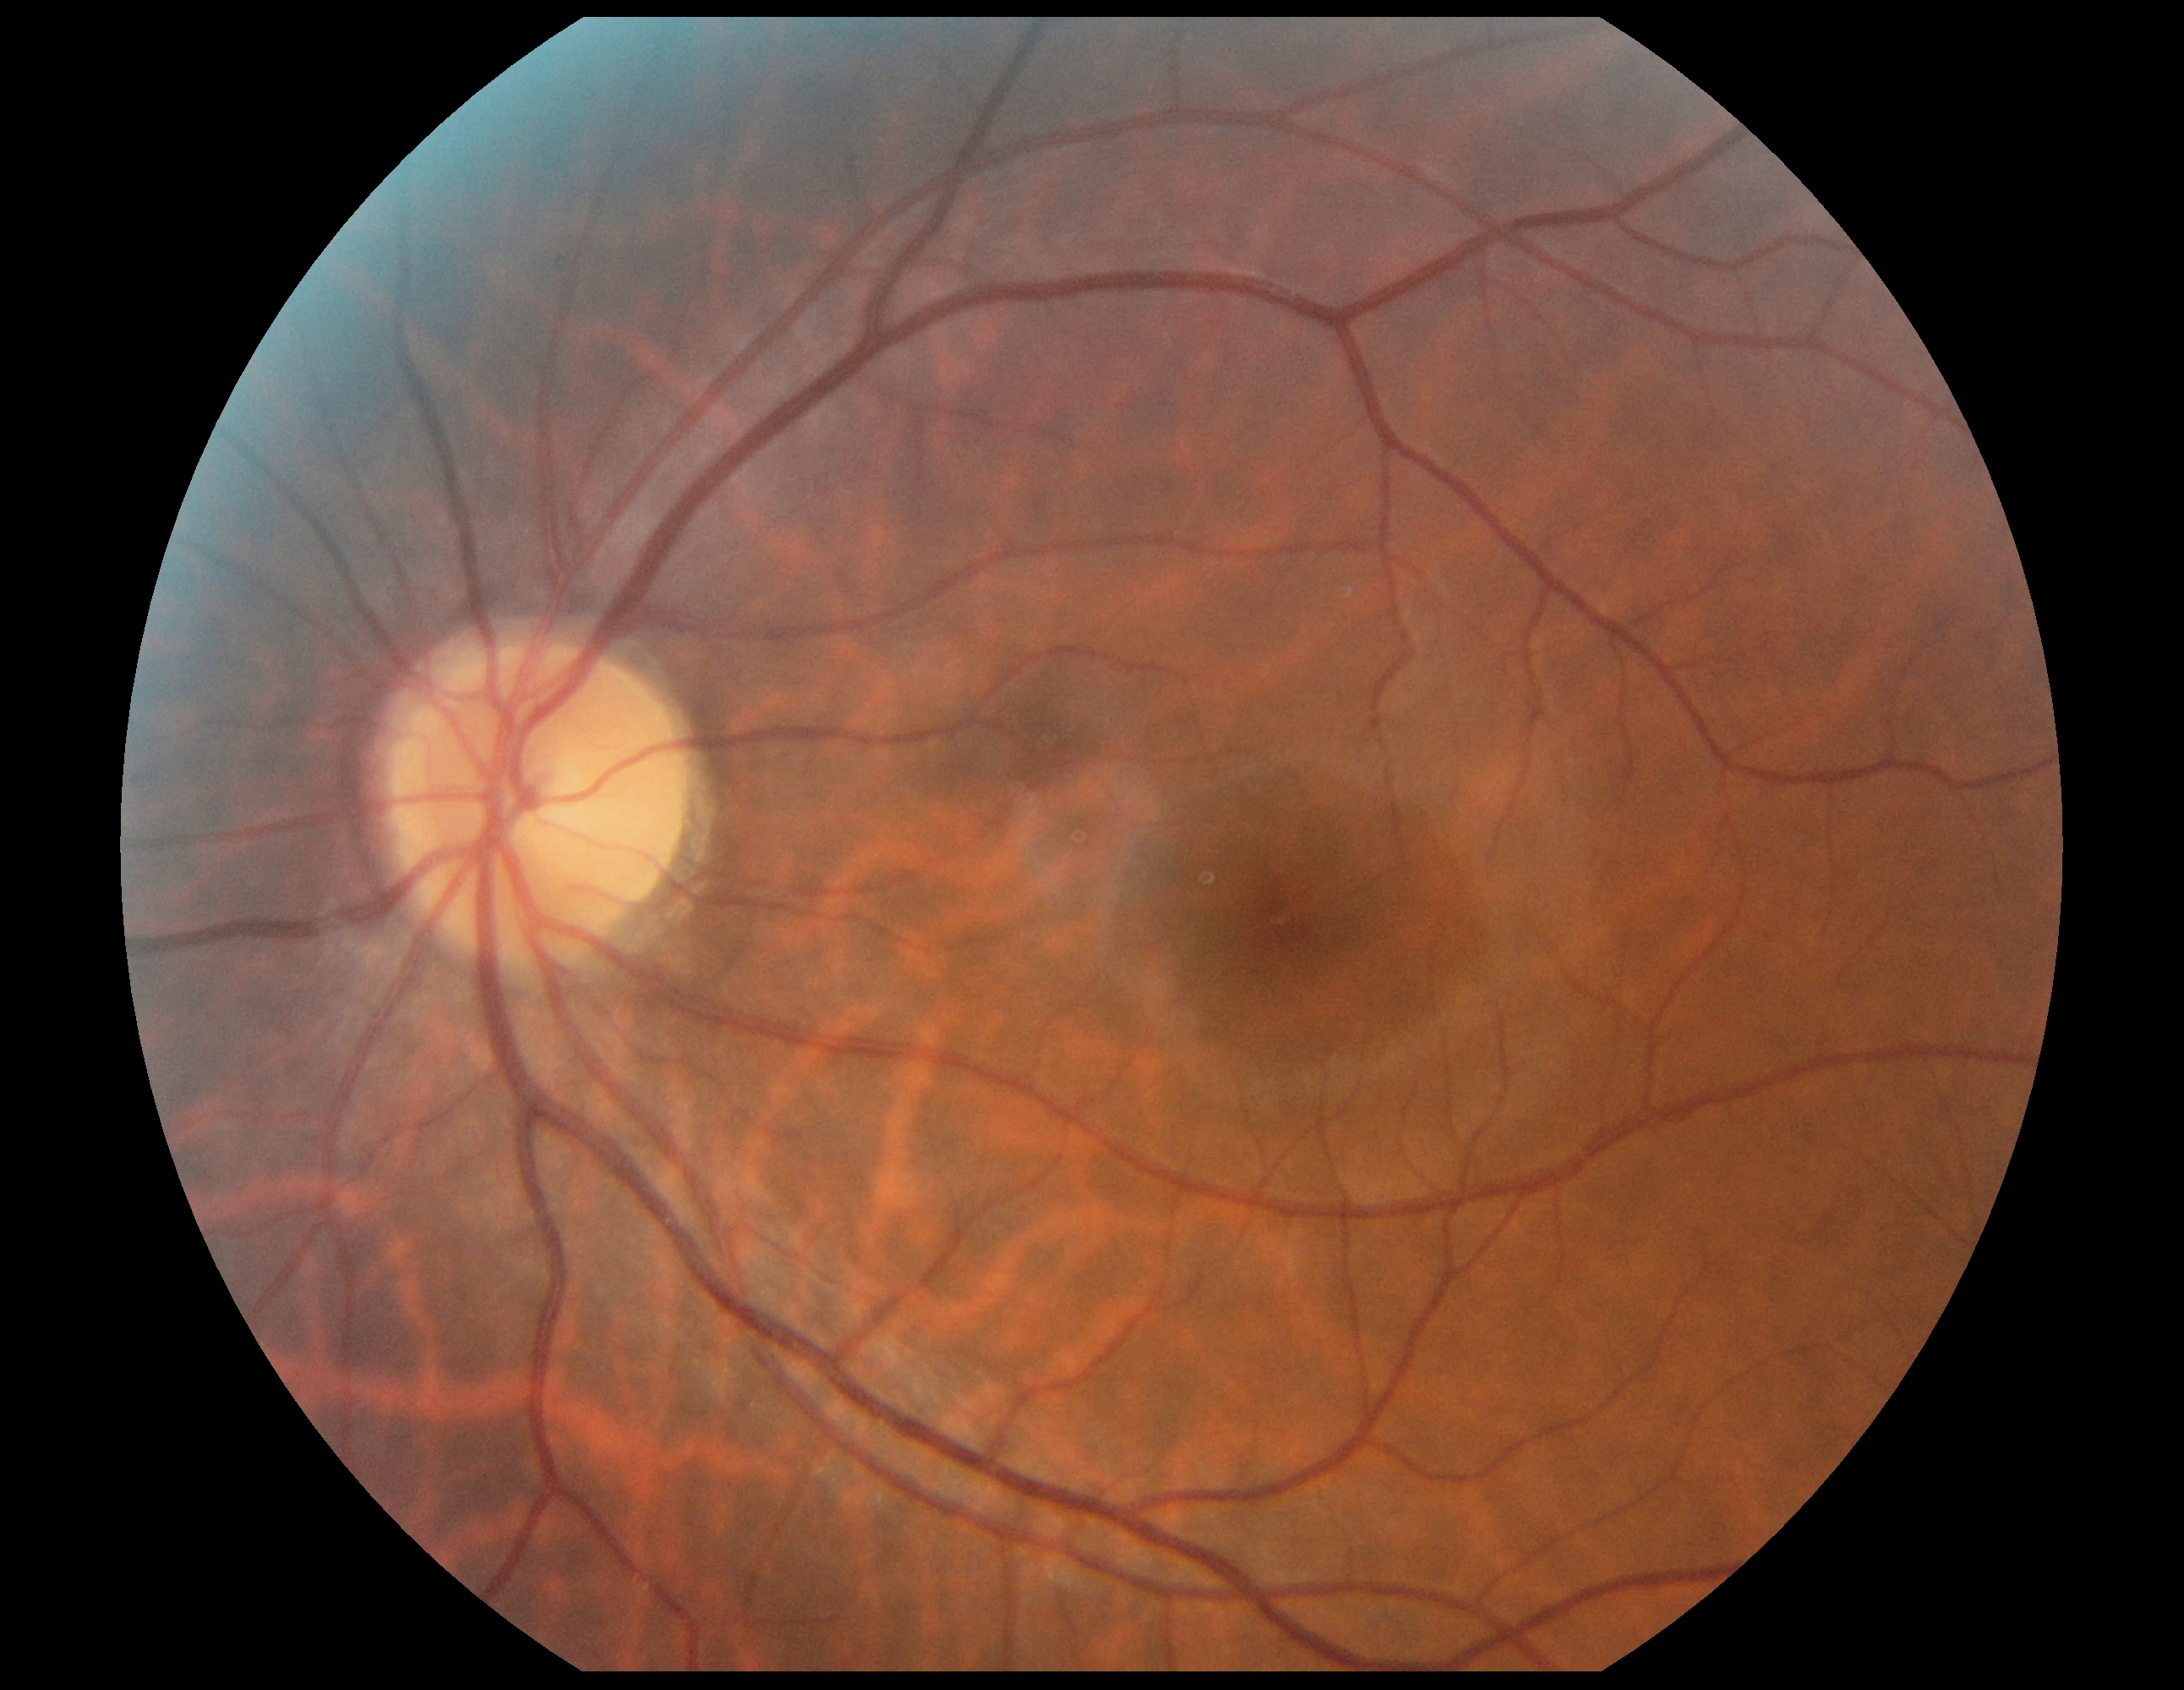
DR severity: 0 — no visible signs of diabetic retinopathy.